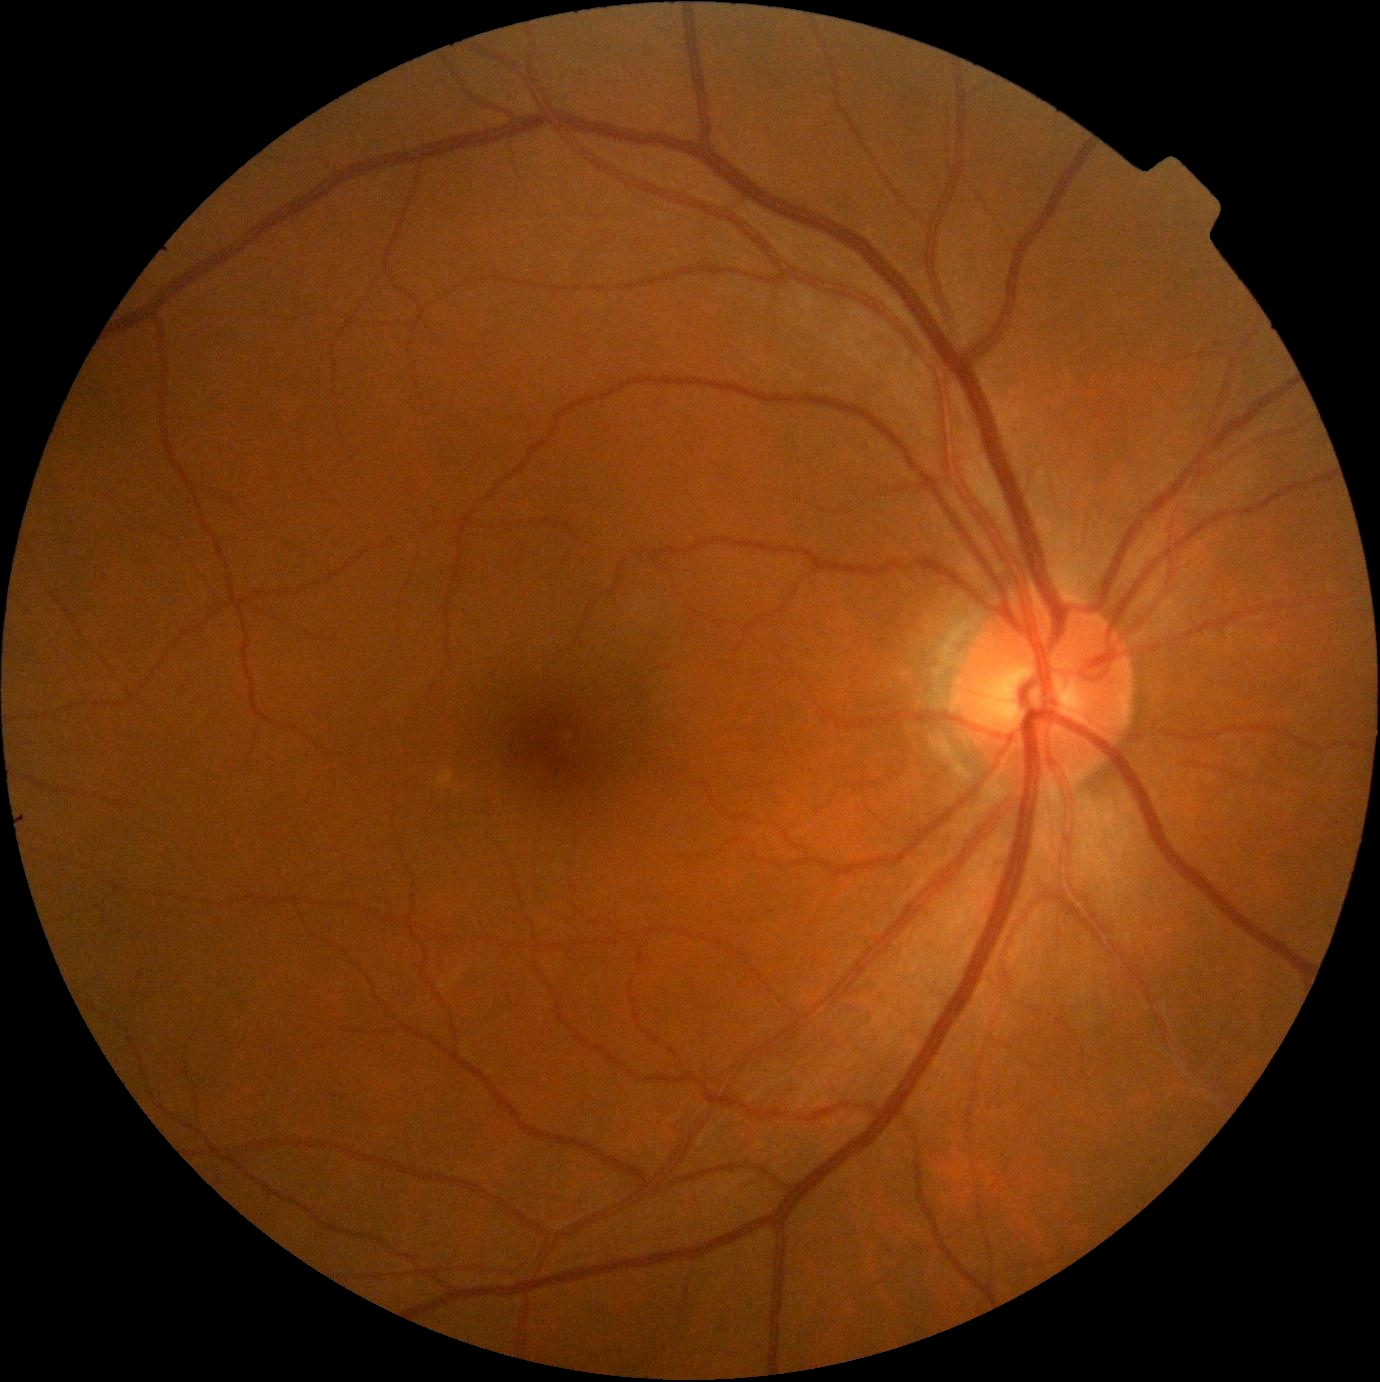 No apparent diabetic retinopathy. Diabetic retinopathy is grade 0 (no apparent retinopathy).